Wide-field fundus photograph from neonatal ROP screening · image size 640x480 · 130° field of view (Clarity RetCam 3): 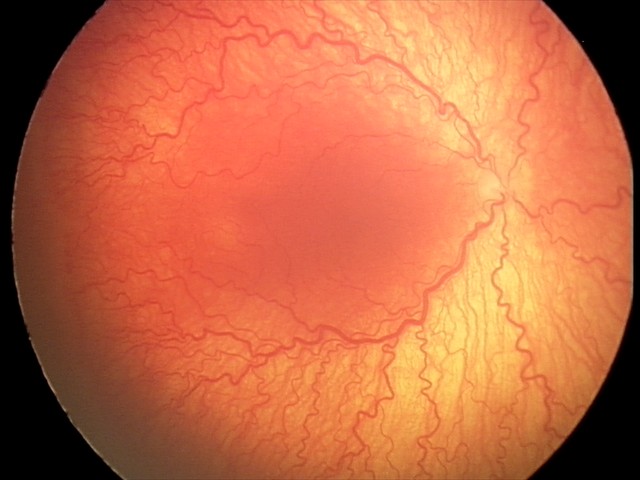 Plus disease present.
Diagnosis from this screening exam: A-ROP (aggressive ROP).